2228 by 1652 pixels. 50° field of view. Acquired with a Topcon TRC-50DX: 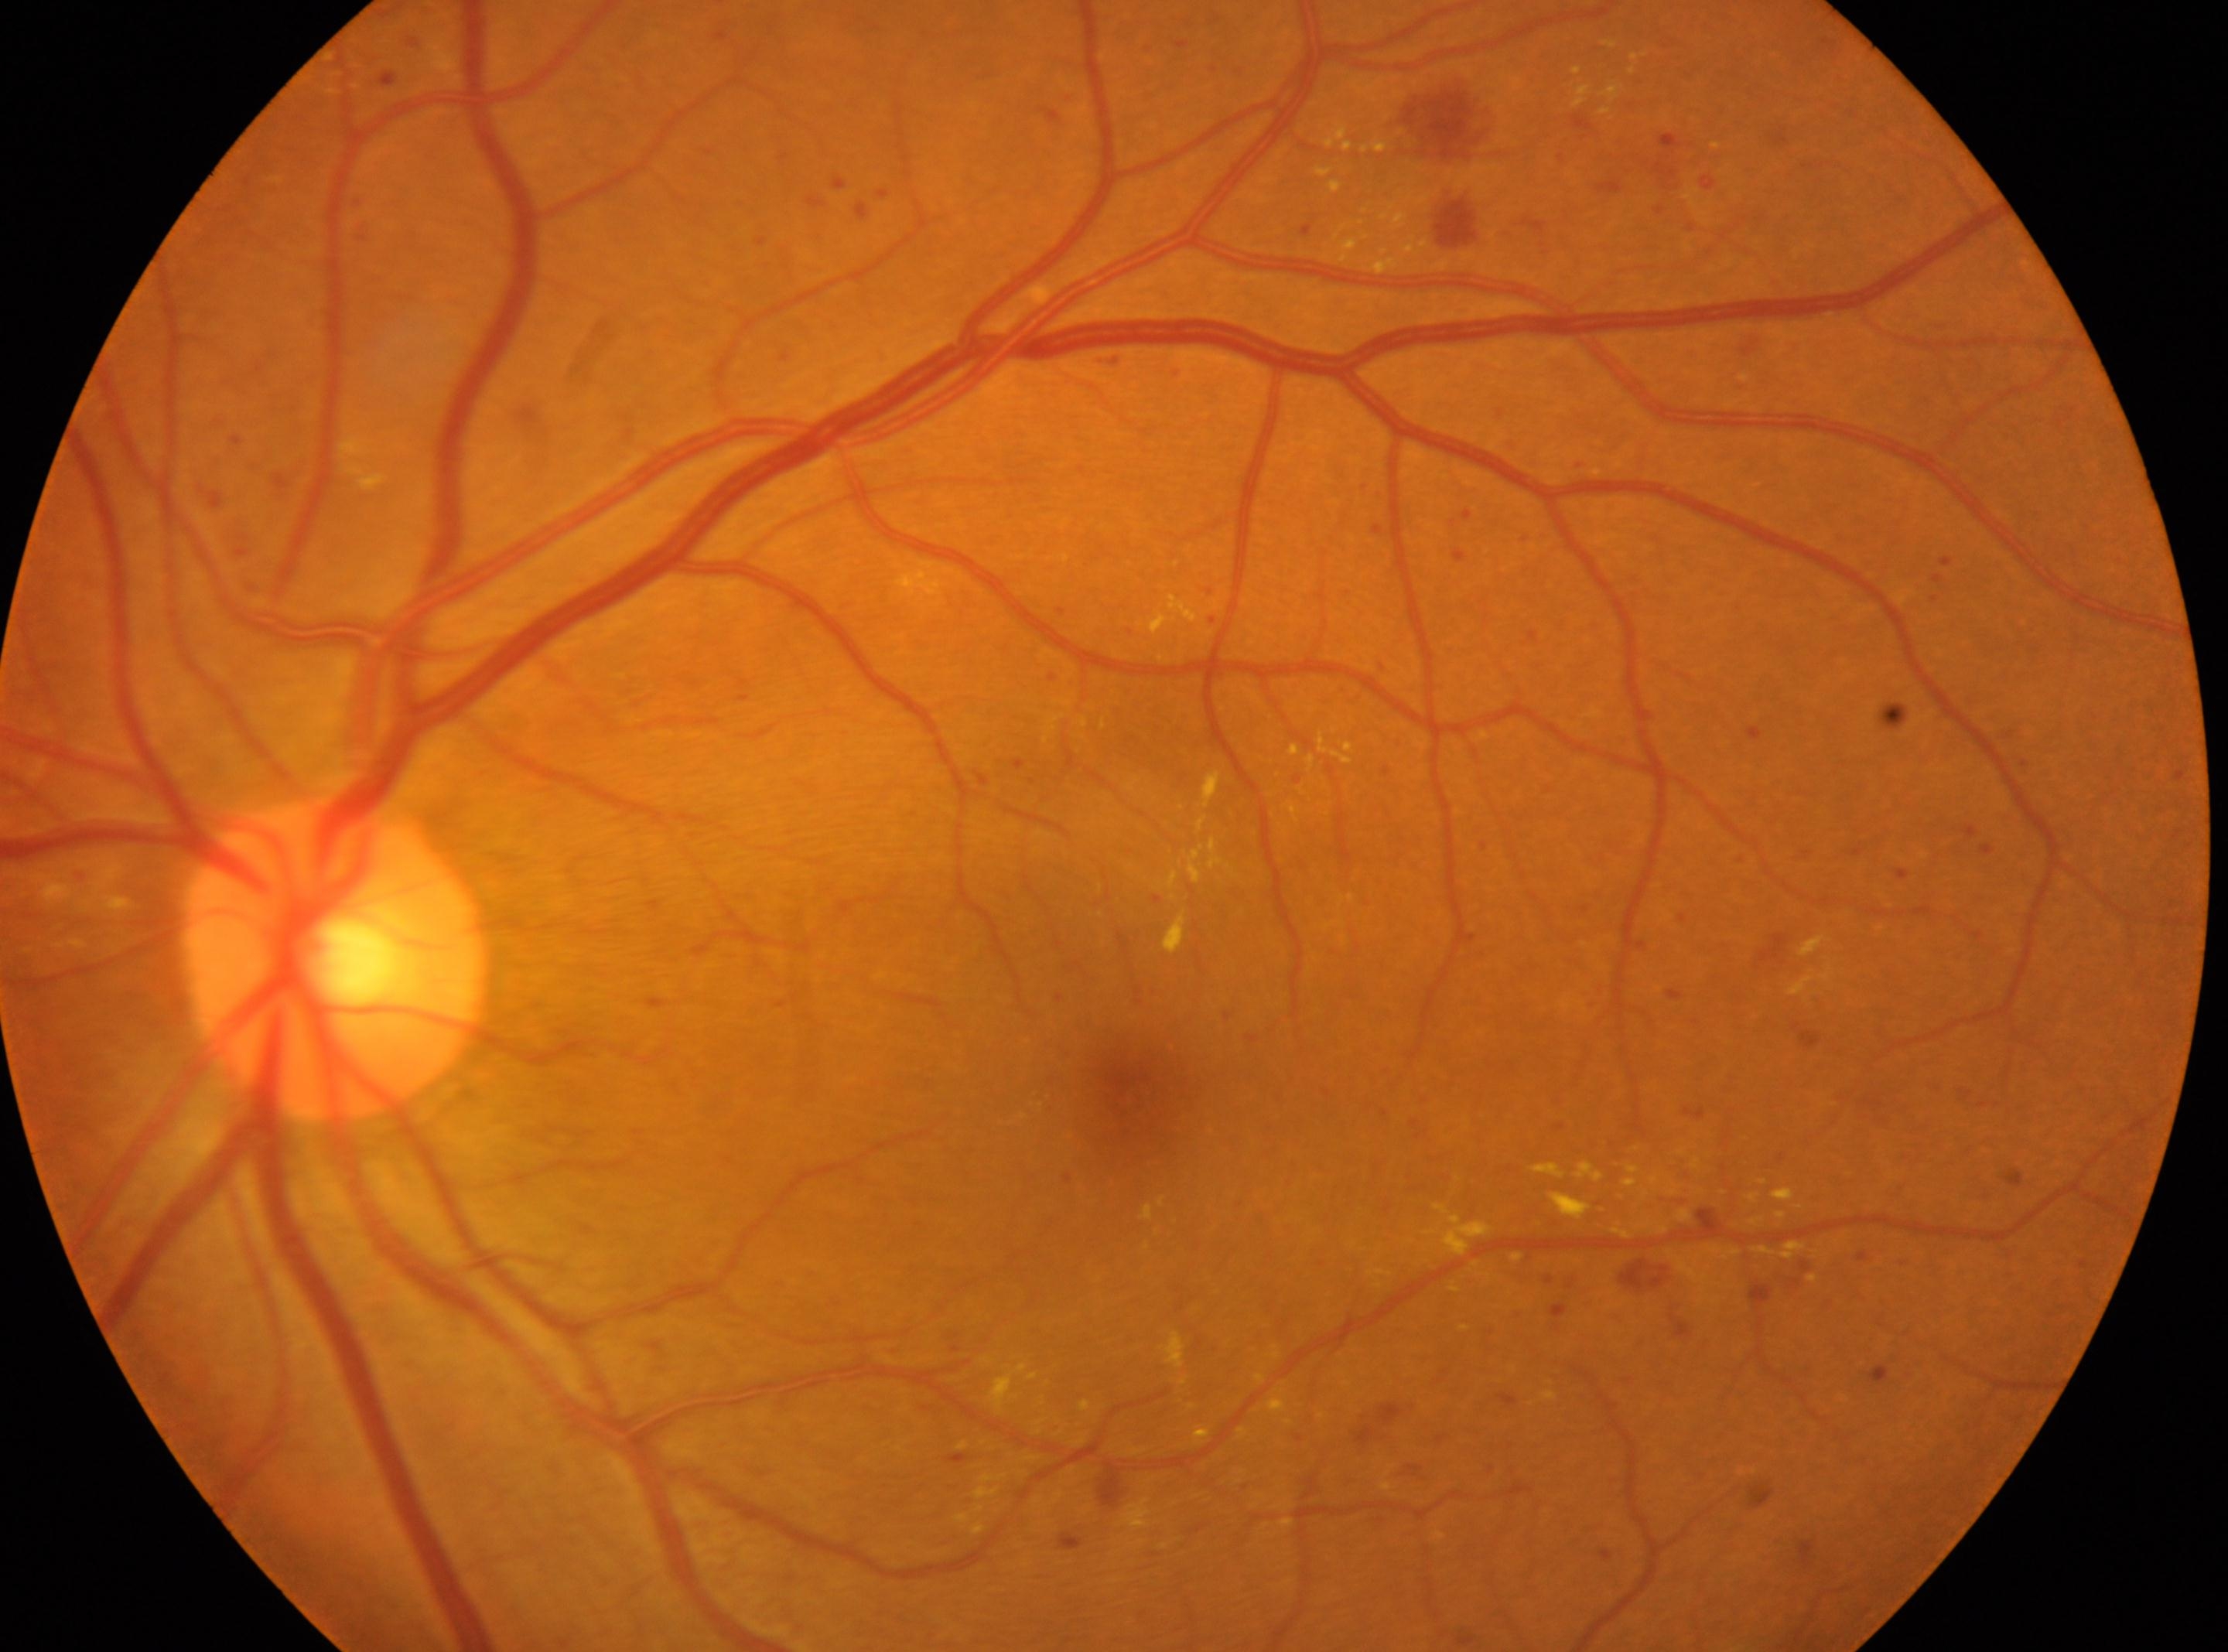 fovea centralis = 1125, 1097; optic disc center = 333, 958; diabetic retinopathy (DR) = moderate non-proliferative diabetic retinopathy (grade 2) — more than just microaneurysms but less than severe NPDR; laterality = left.